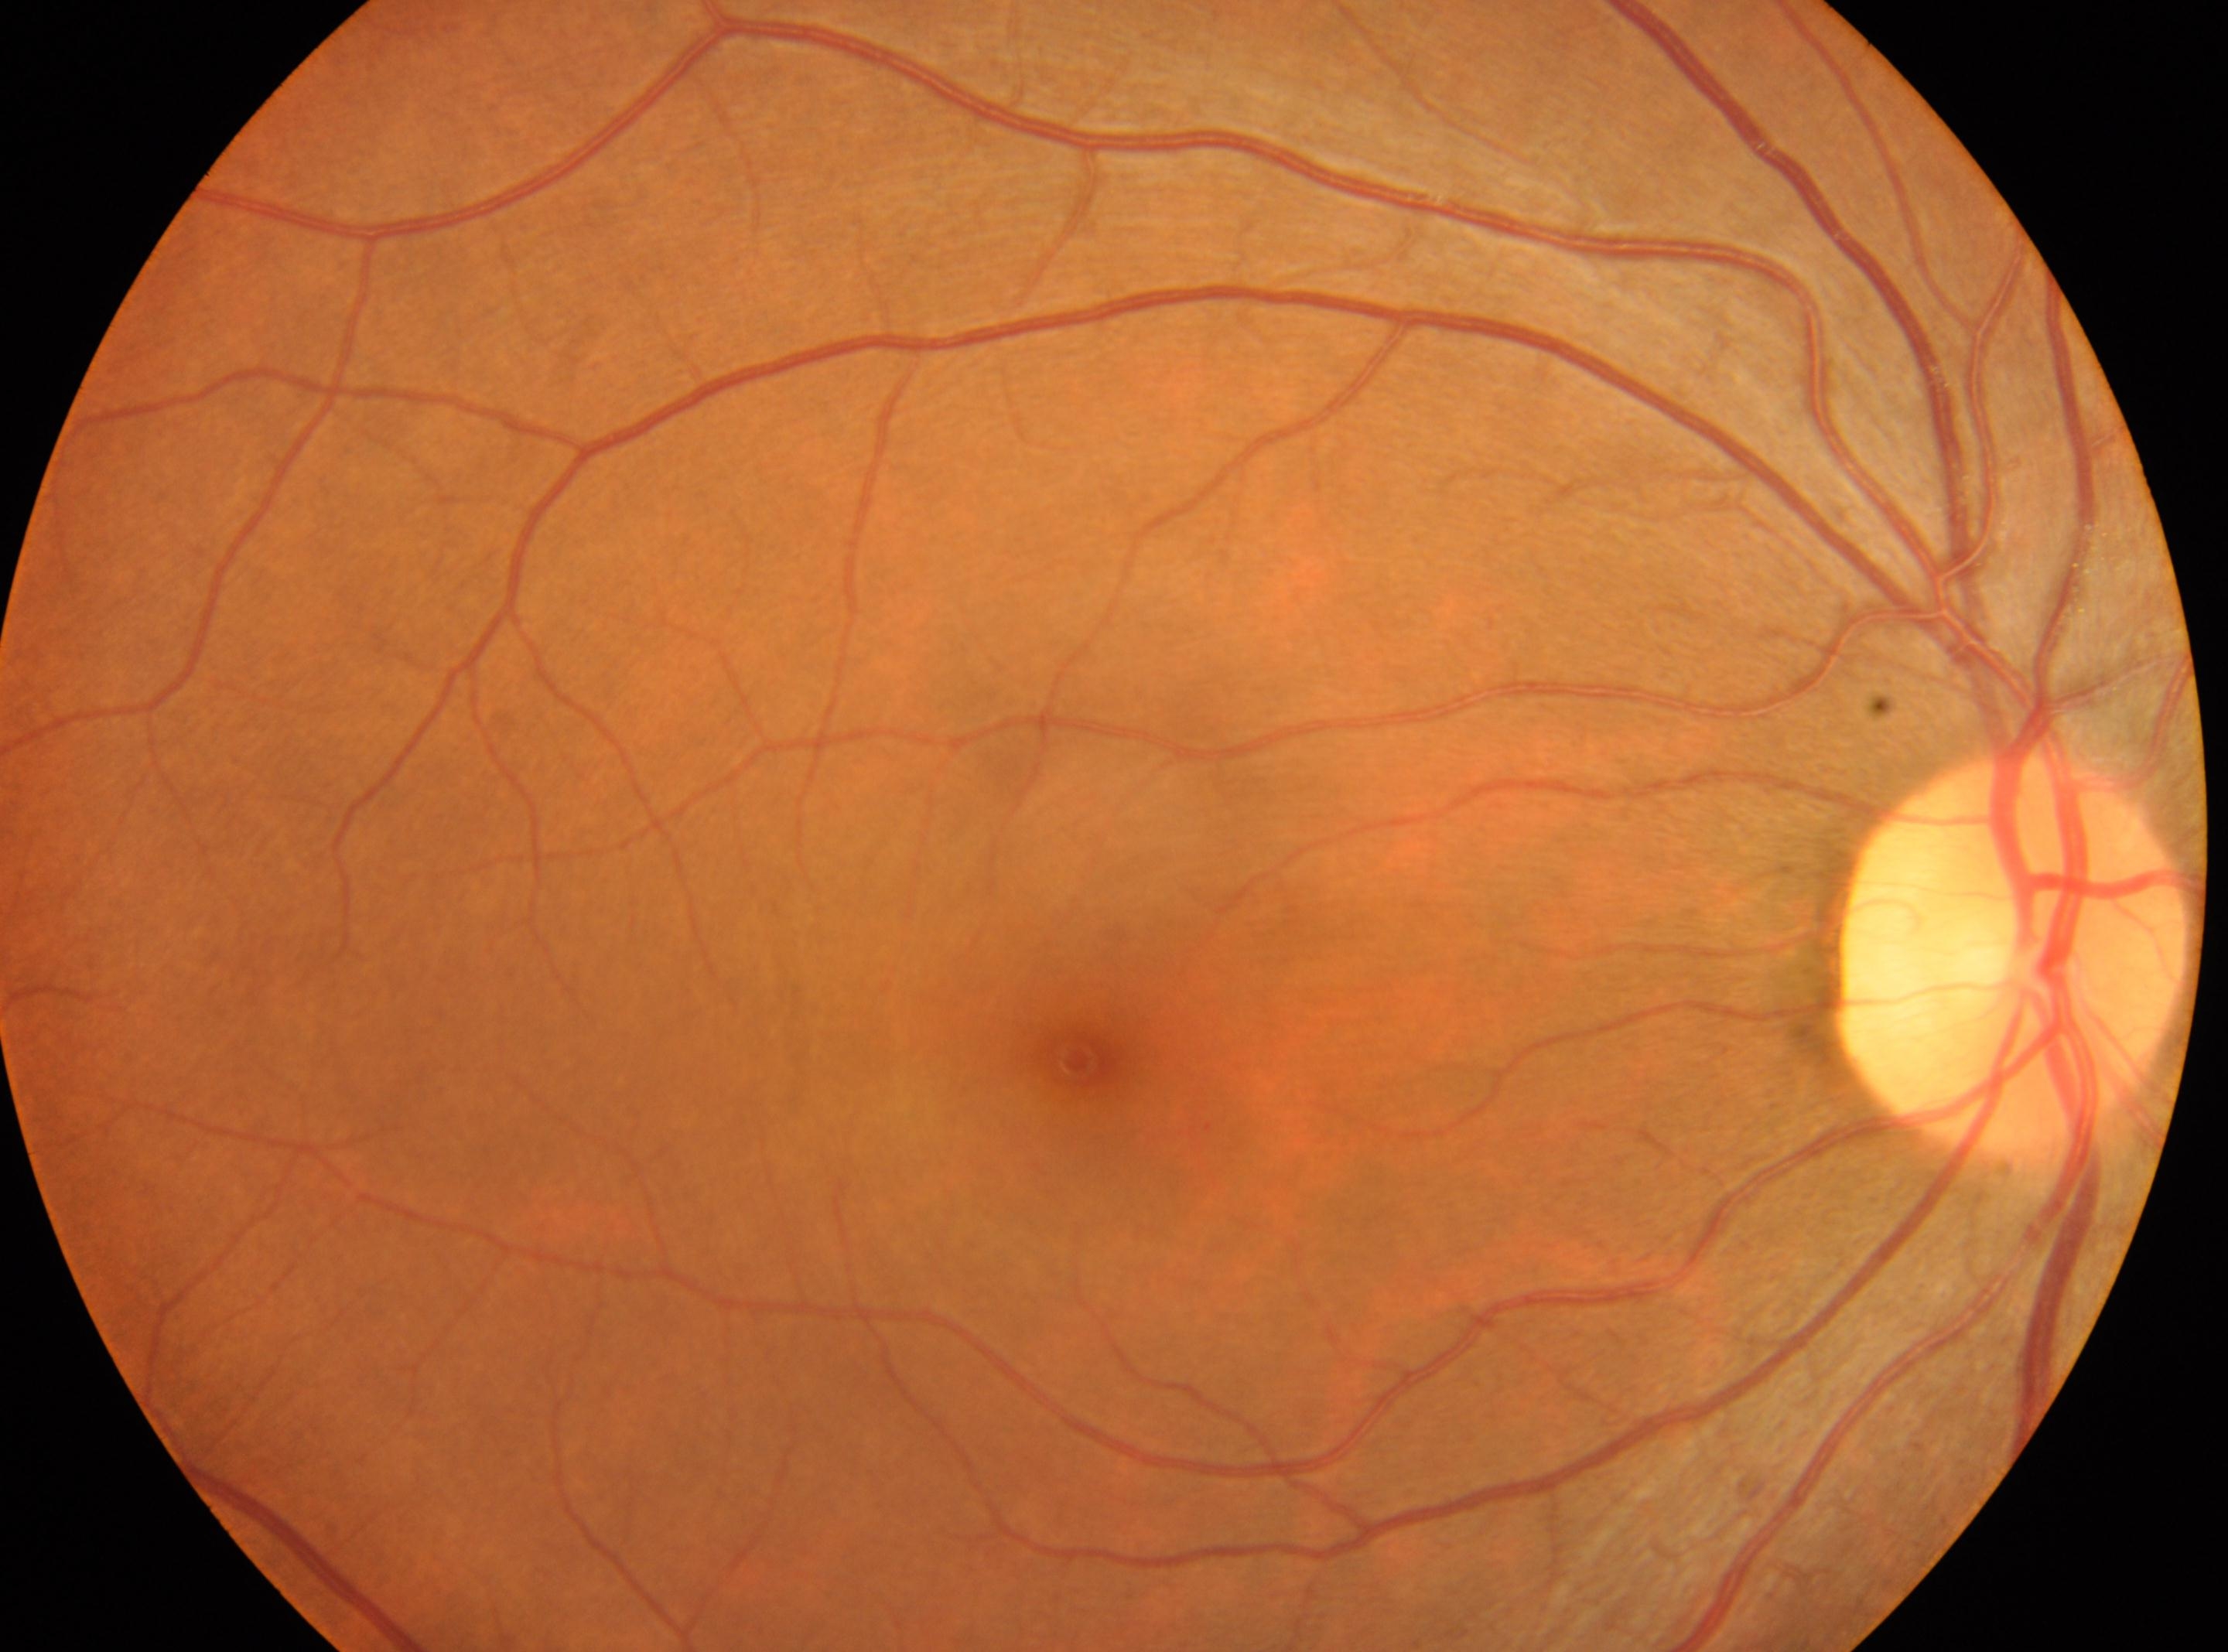

Q: What is the DR grade?
A: no apparent diabetic retinopathy (grade 0)
Q: DR impression?
A: No apparent diabetic retinopathy
Q: Locate the fovea.
A: (1075,1060)
Q: Where is the optic disc?
A: (2014,953)
Q: Right or left eye?
A: right eye